Color fundus image:
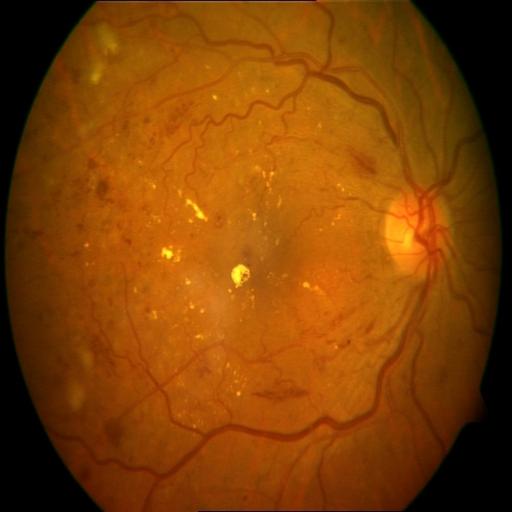

Three findings. The image shows exudation (EDN), hemorrhagic retinopathy (HR), and cotton wool spots (CWS).